Modified Davis grading.
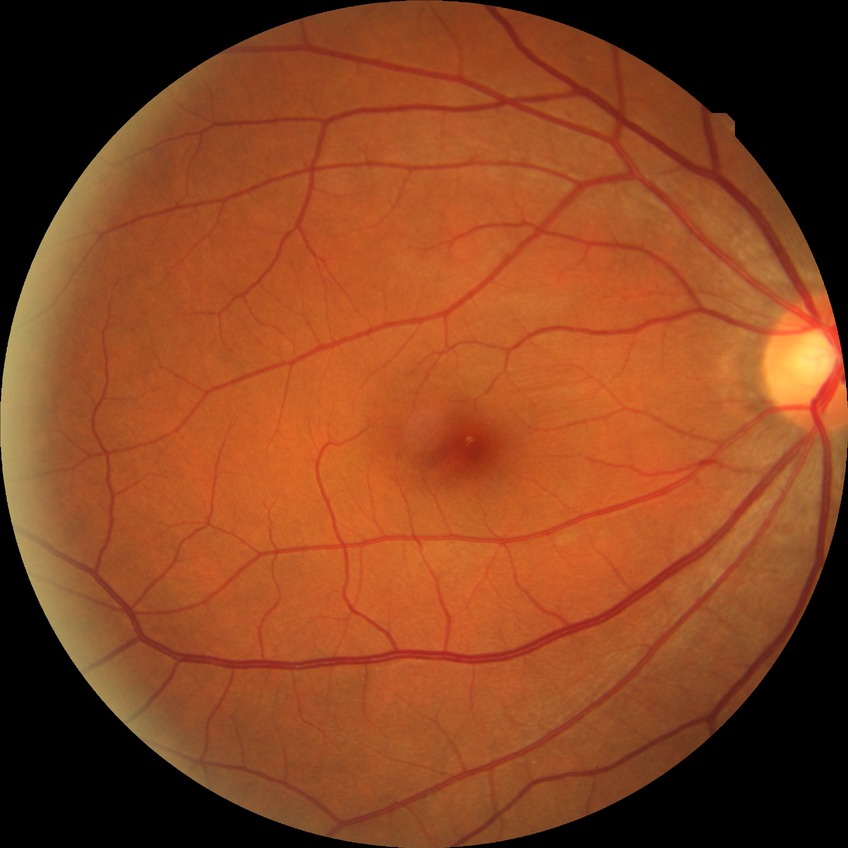 No signs of diabetic retinopathy. DR grade is NDR.